Captured with the Natus RetCam Envision (130° field of view) · infant wide-field retinal image · 1440x1080px: 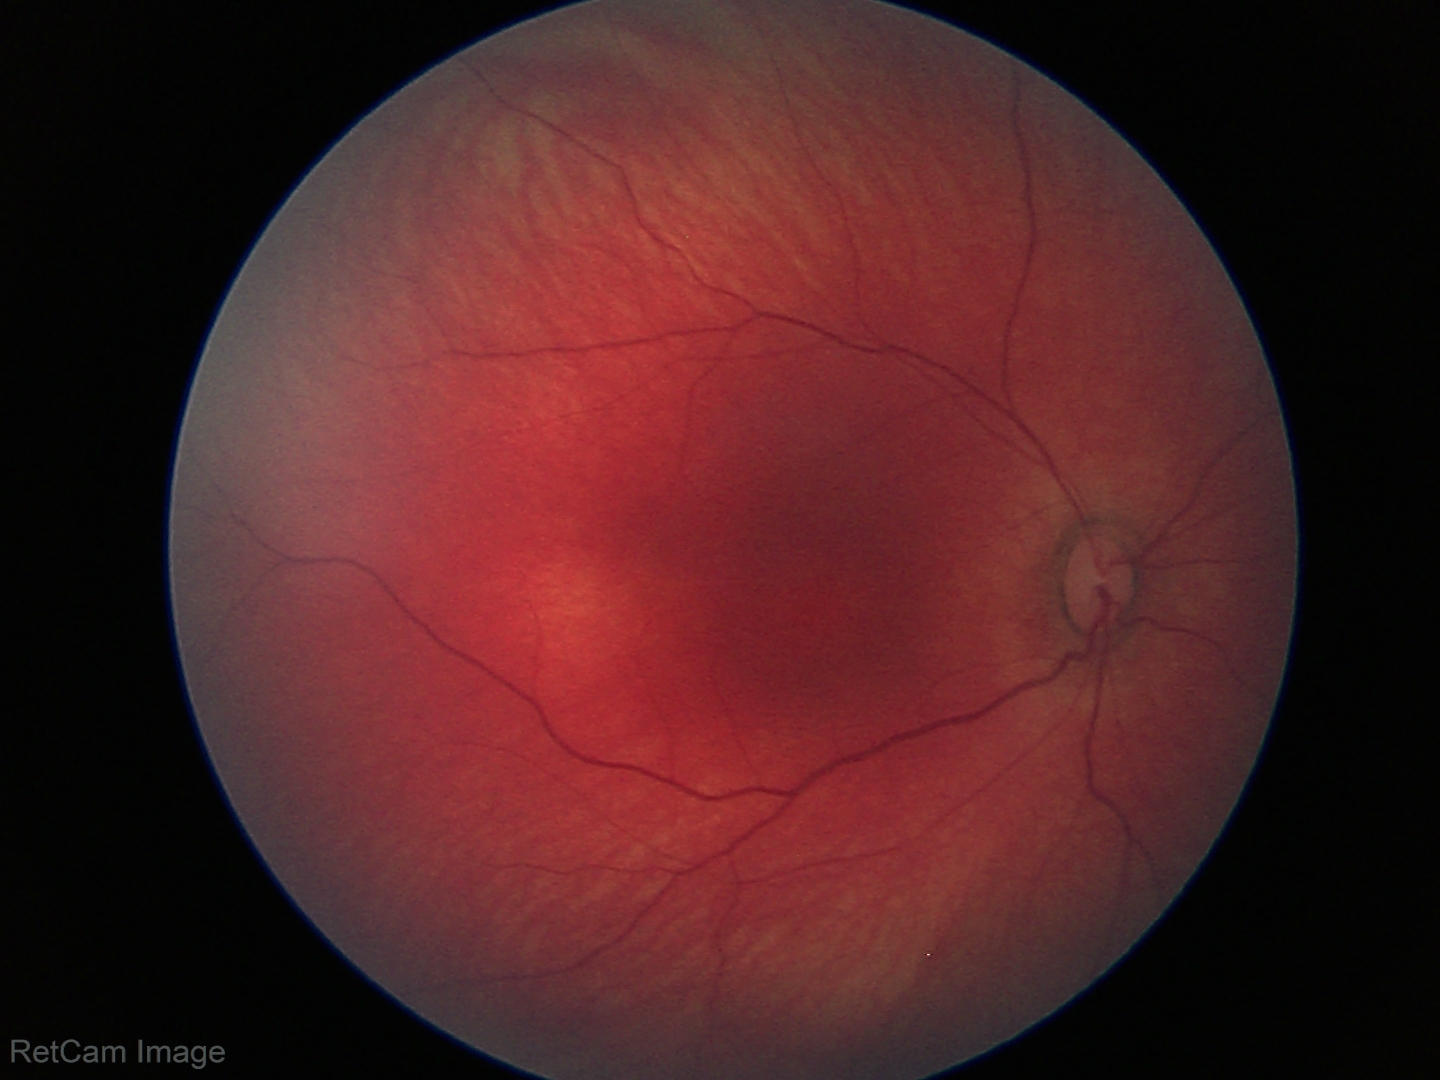 Physiological retinal appearance for postconceptual age.